Image size 848x848 · color fundus image · camera: NIDEK AFC-230
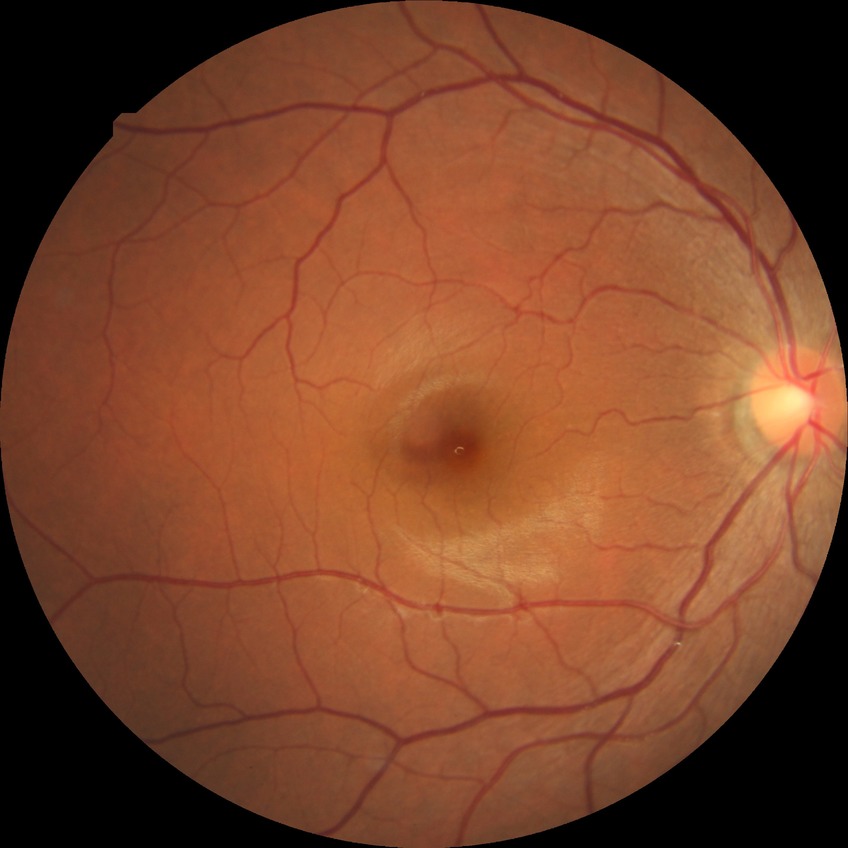

diabetic retinopathy stage = no diabetic retinopathy.